Wide-field fundus photograph from neonatal ROP screening · Phoenix ICON, 100° FOV.
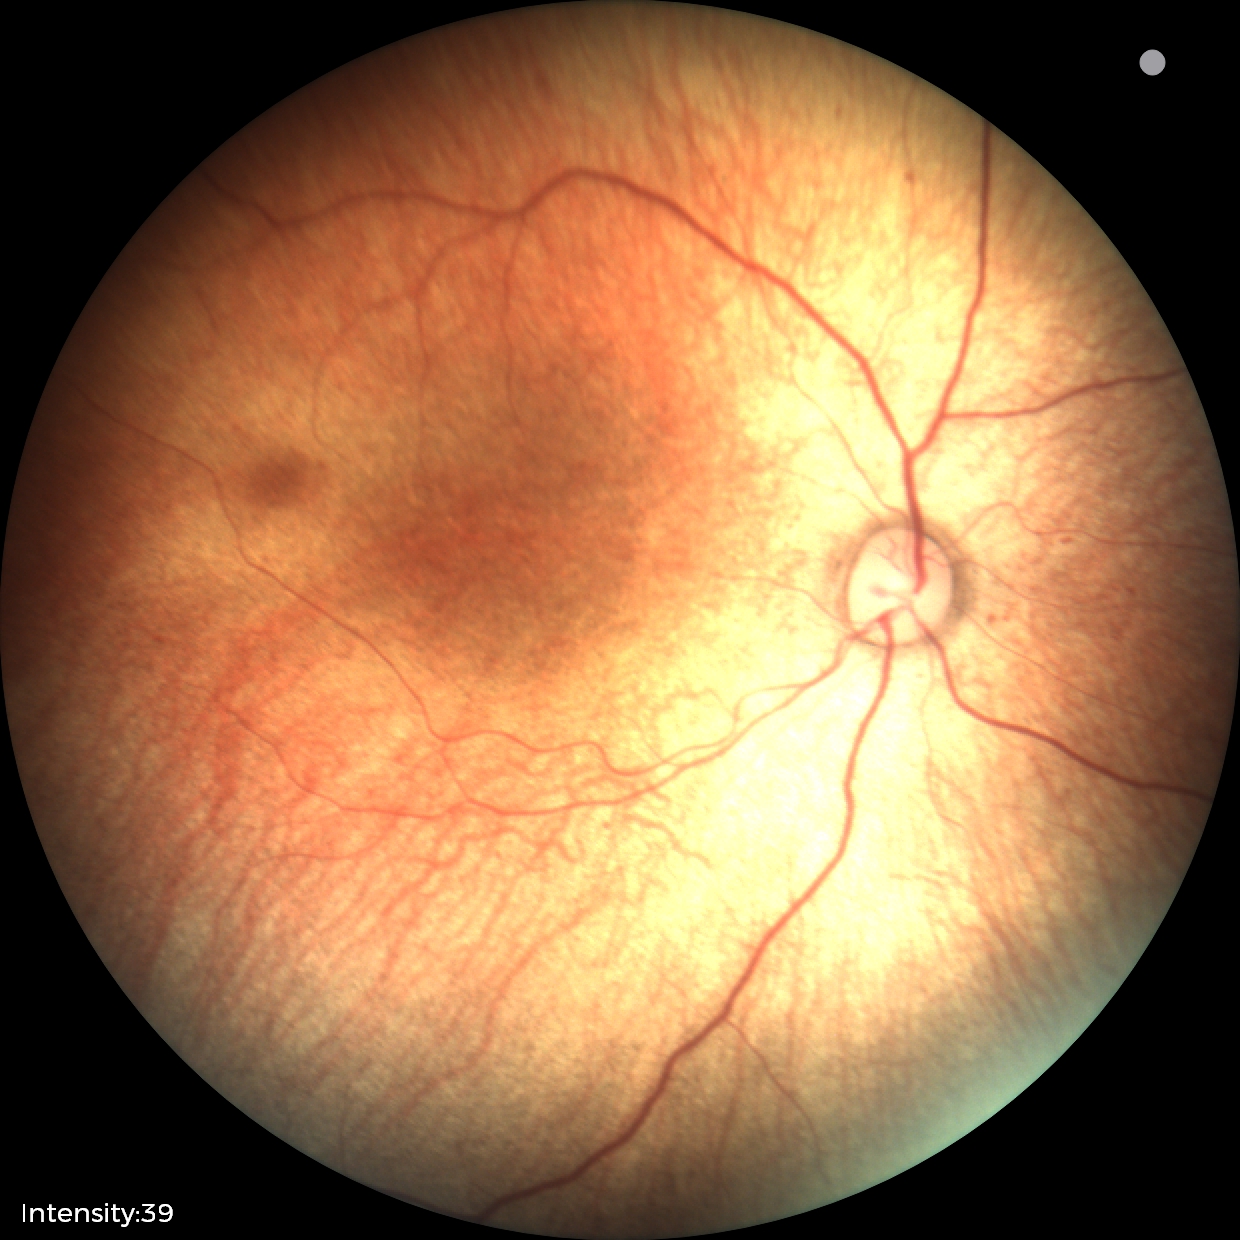 Examination with physiological retinal findings.